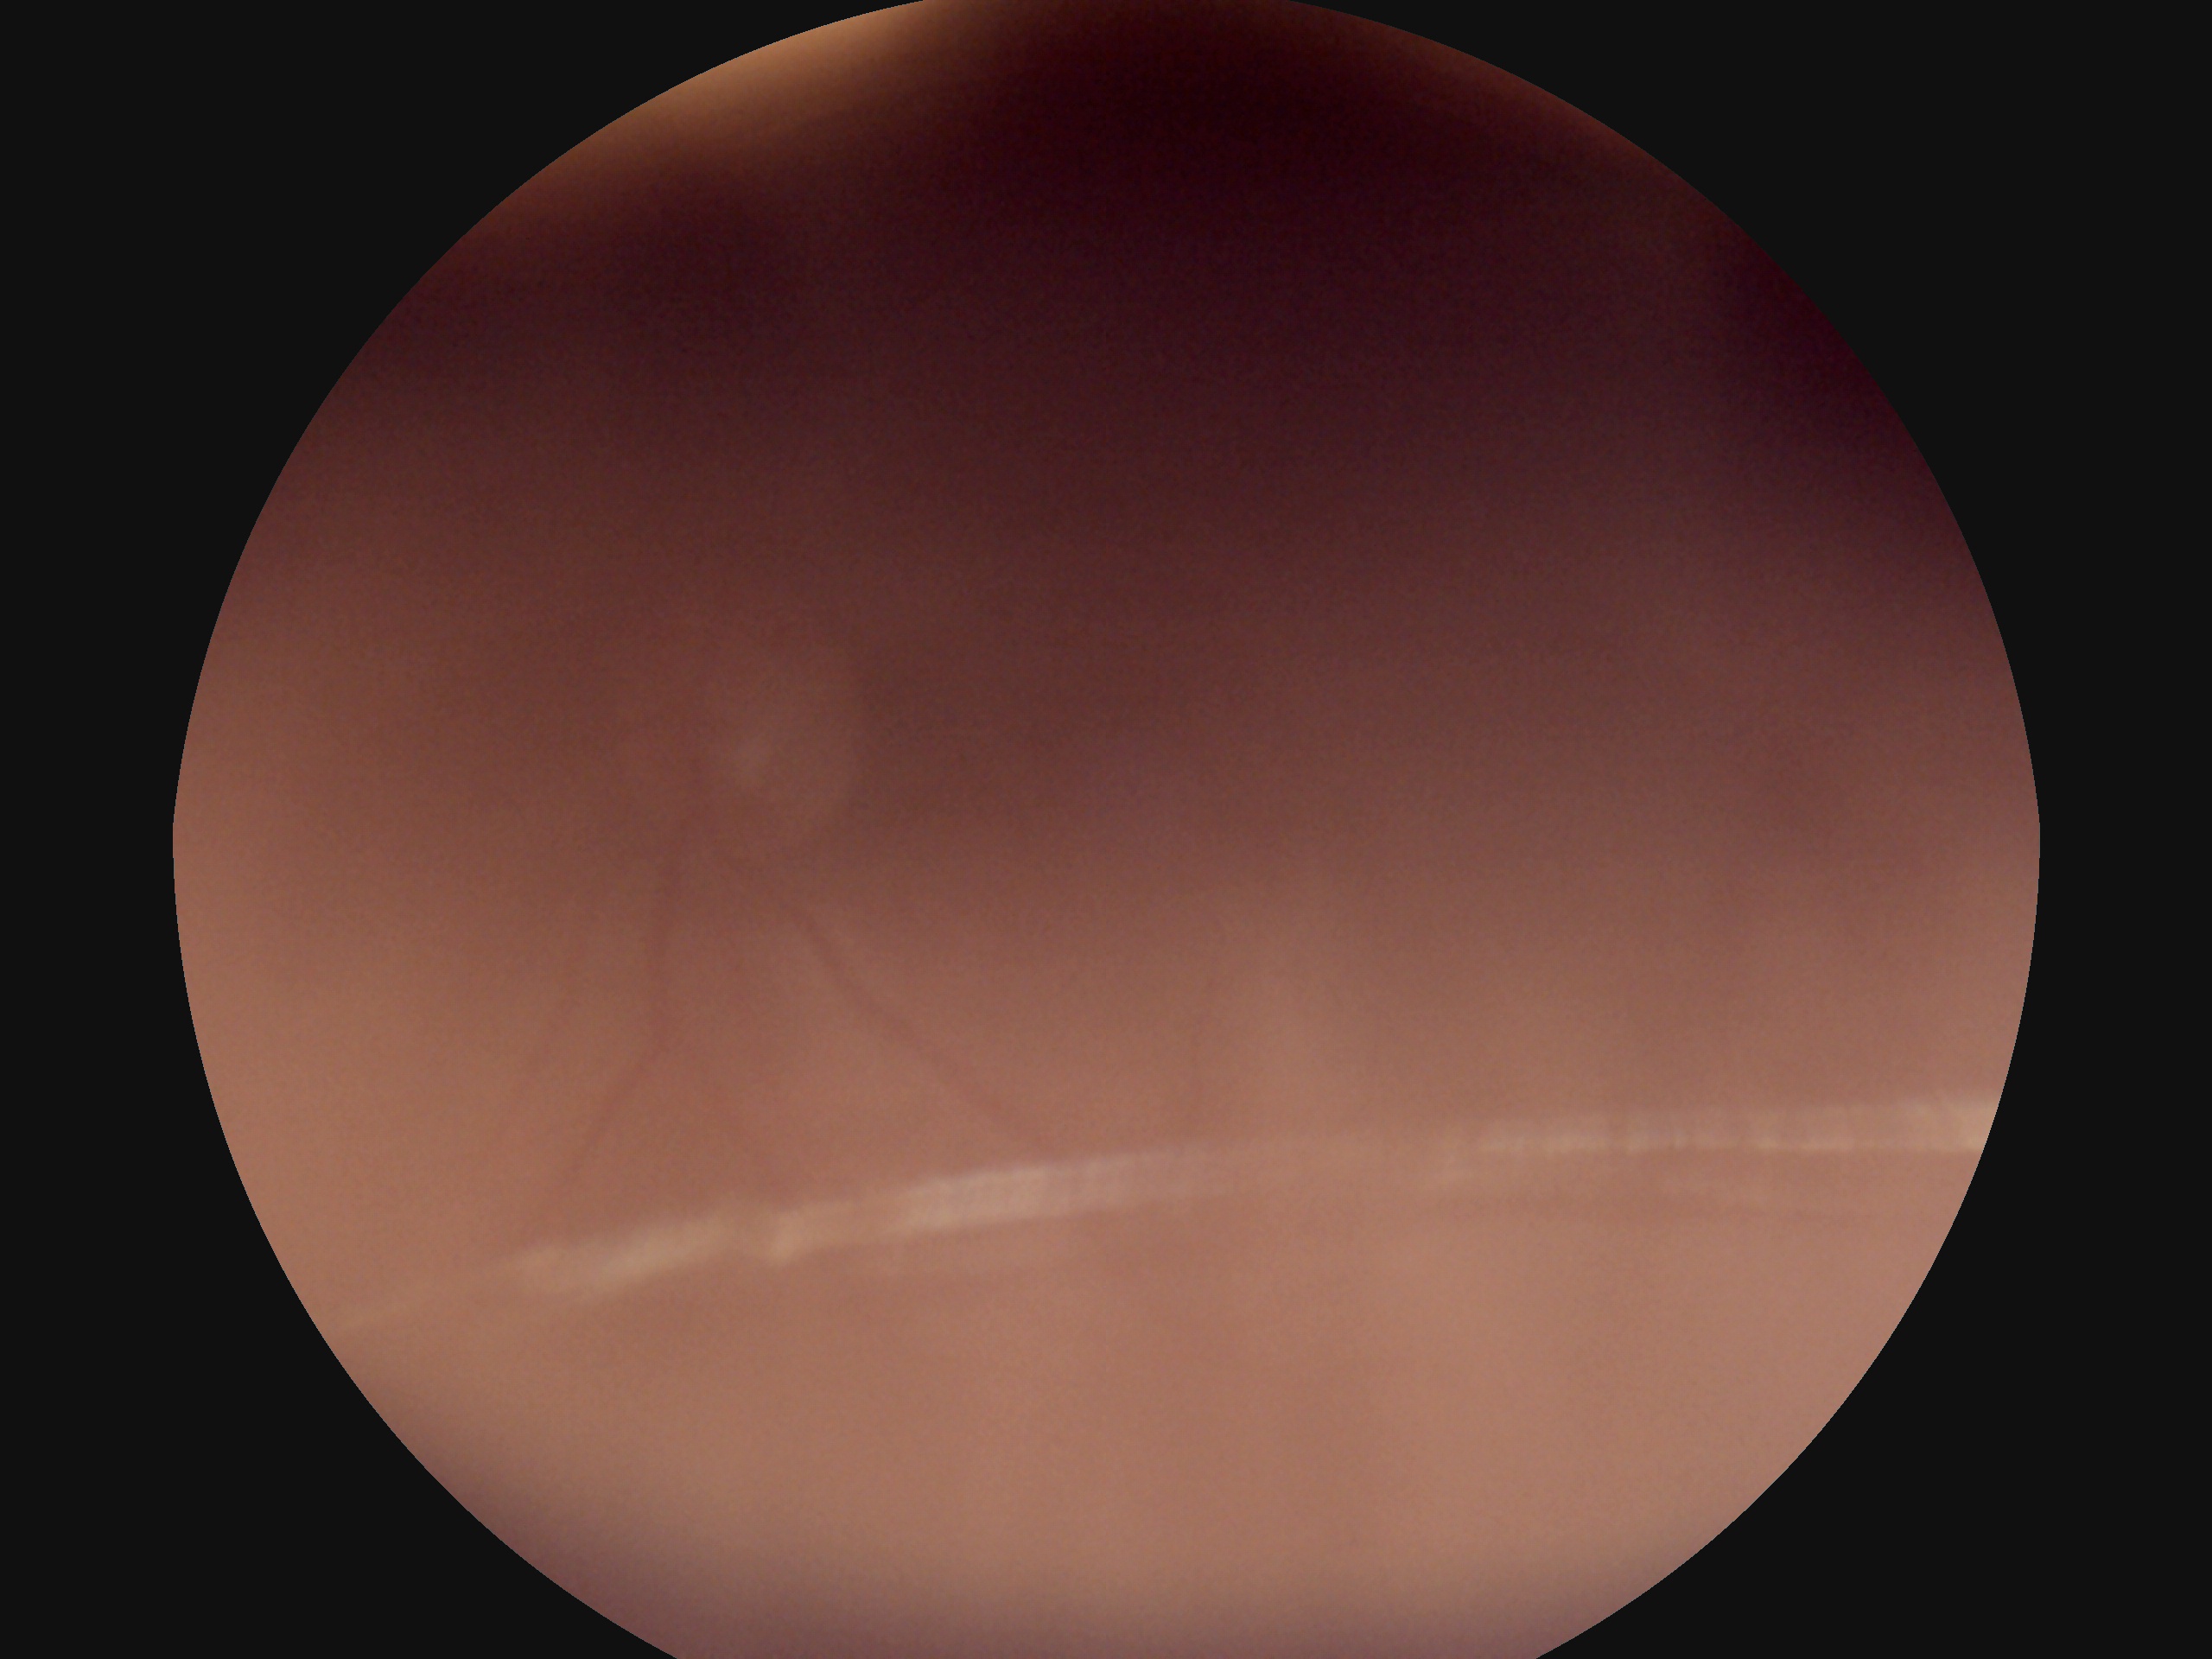
DR stage: ungradable due to poor image quality.
Quality too poor to assess for DR.